Wide-field contact fundus photograph of an infant. Acquired on the Phoenix ICON. 1240 by 1240 pixels: 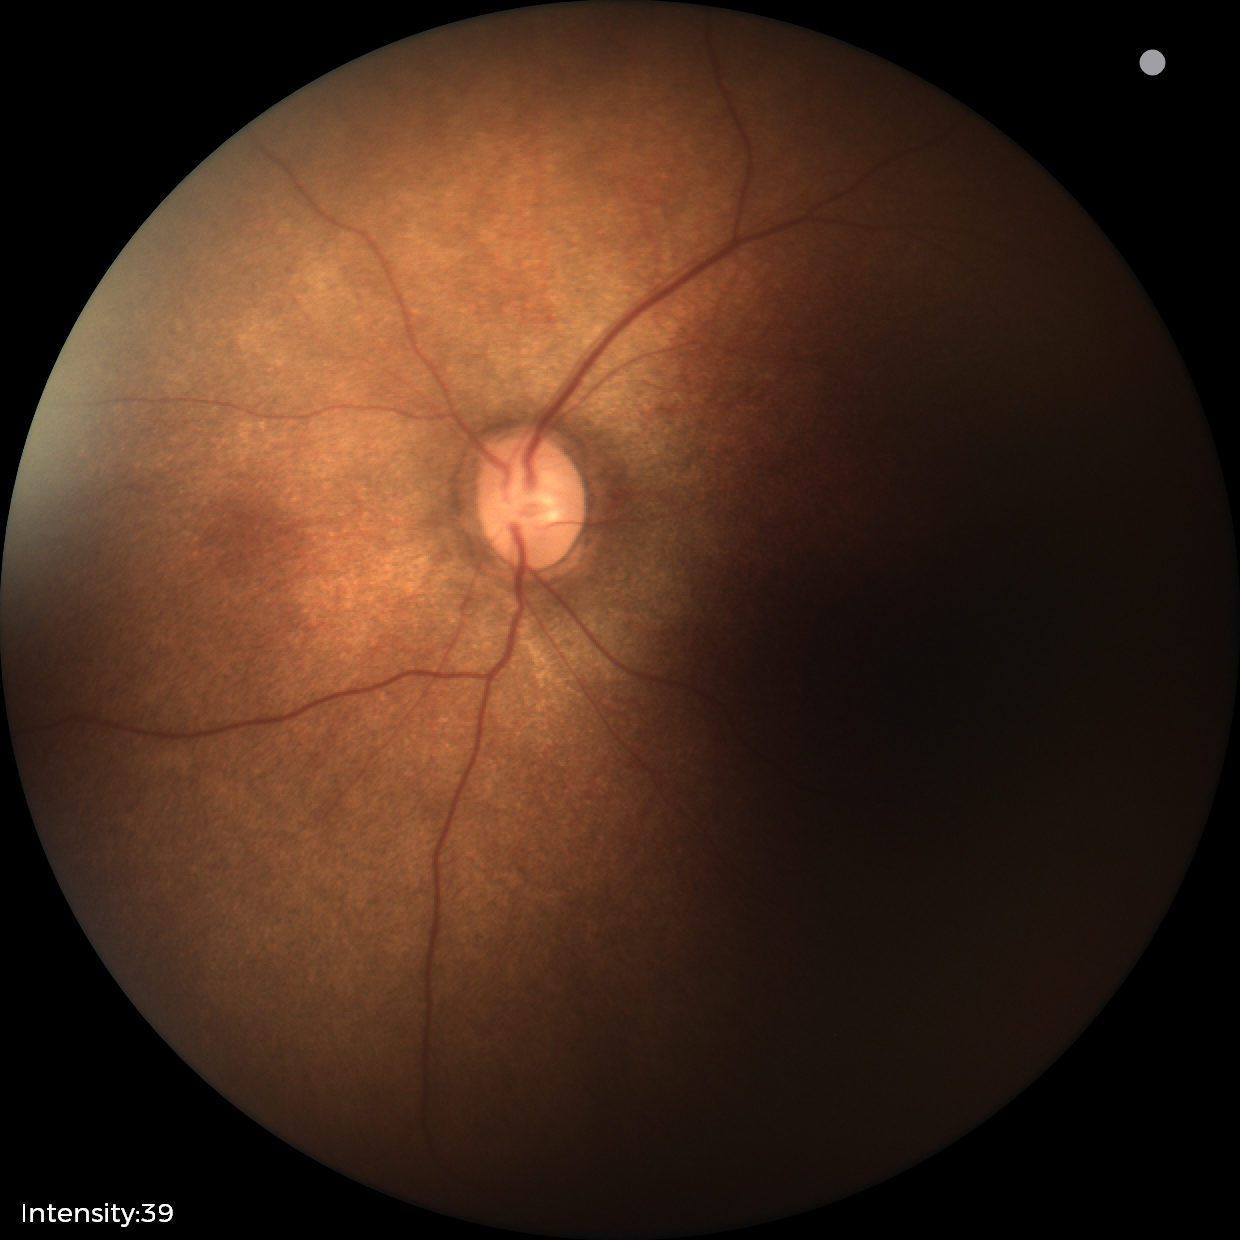 Assessment = no abnormalities.